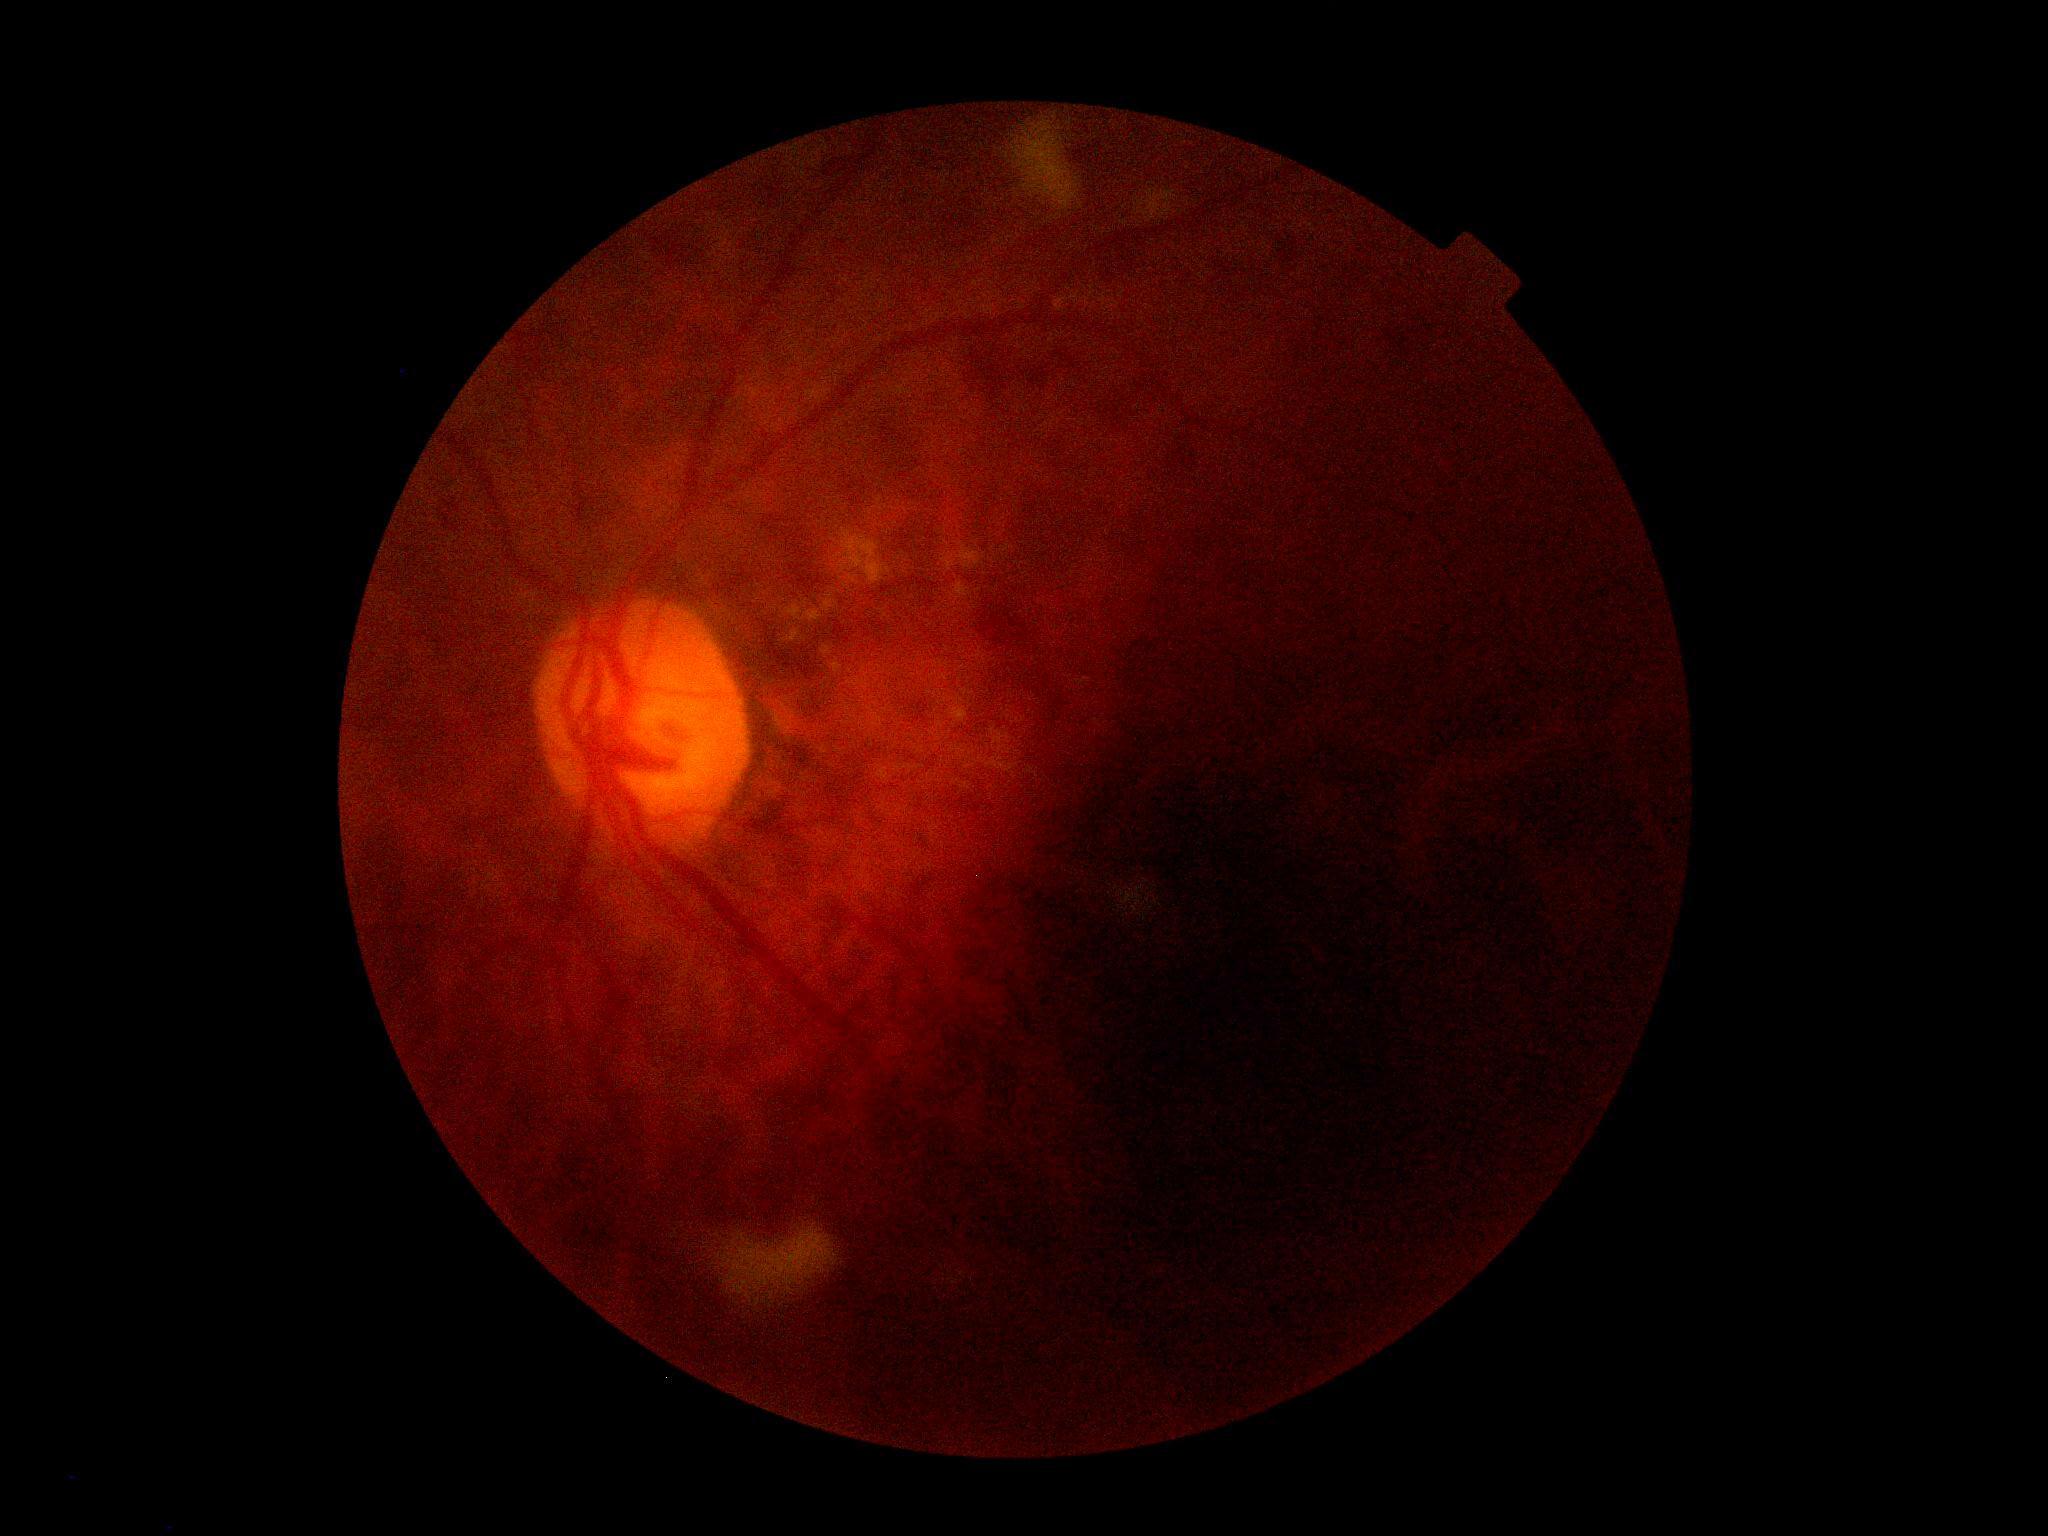 Annotations:
– diabetic retinopathy (DR): grade 2 (moderate NPDR)